Pediatric retinal photograph (wide-field) · 640 x 480 pixels:
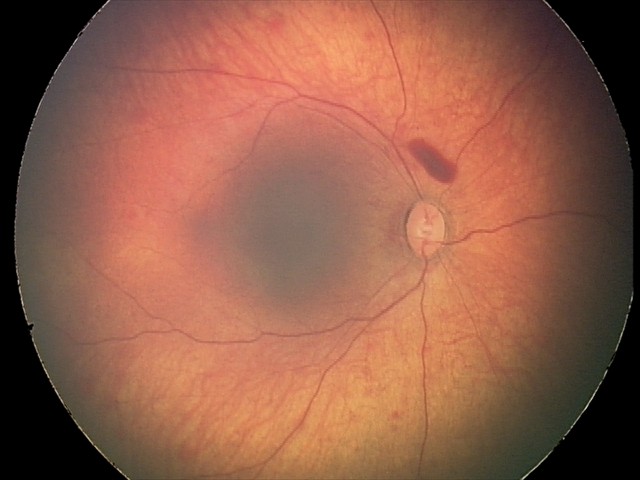 Screening diagnosis = retinal hemorrhages.